Handheld portable fundus camera image: 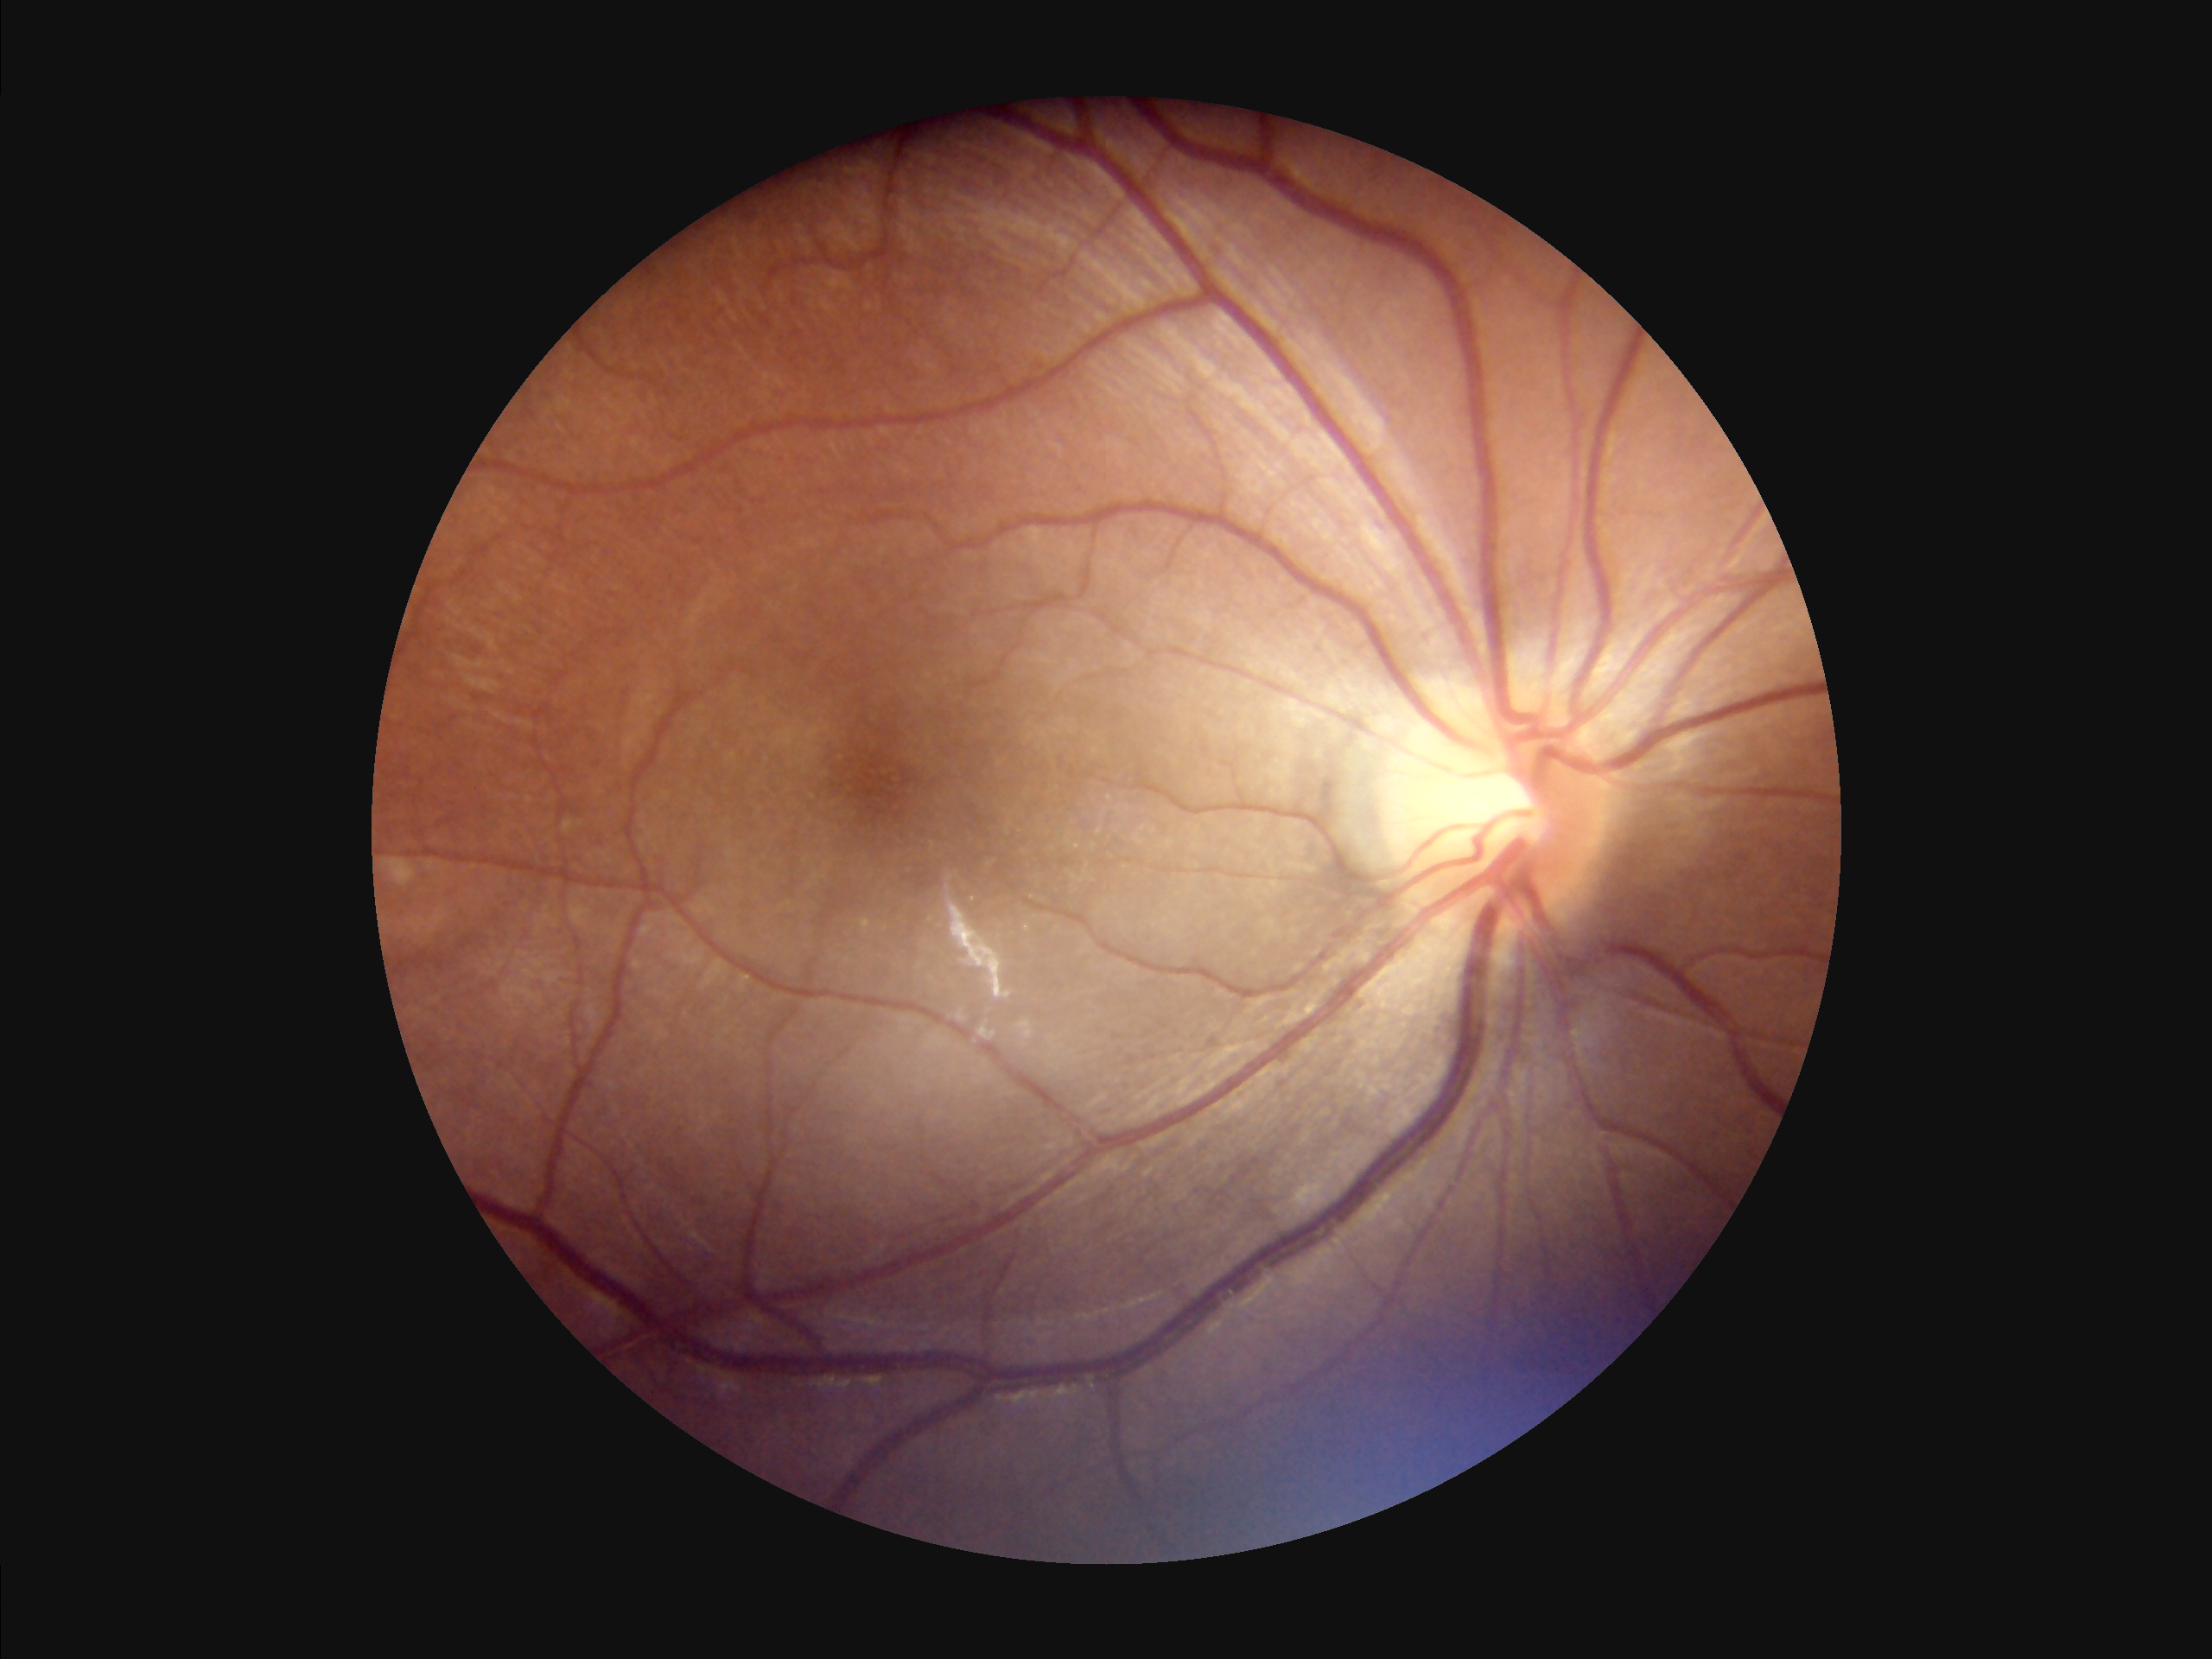
Overall: adequate | Illumination/color: suboptimal | Focus: clear.